No pharmacologic dilation · 848 by 848 pixels · 45-degree field of view:
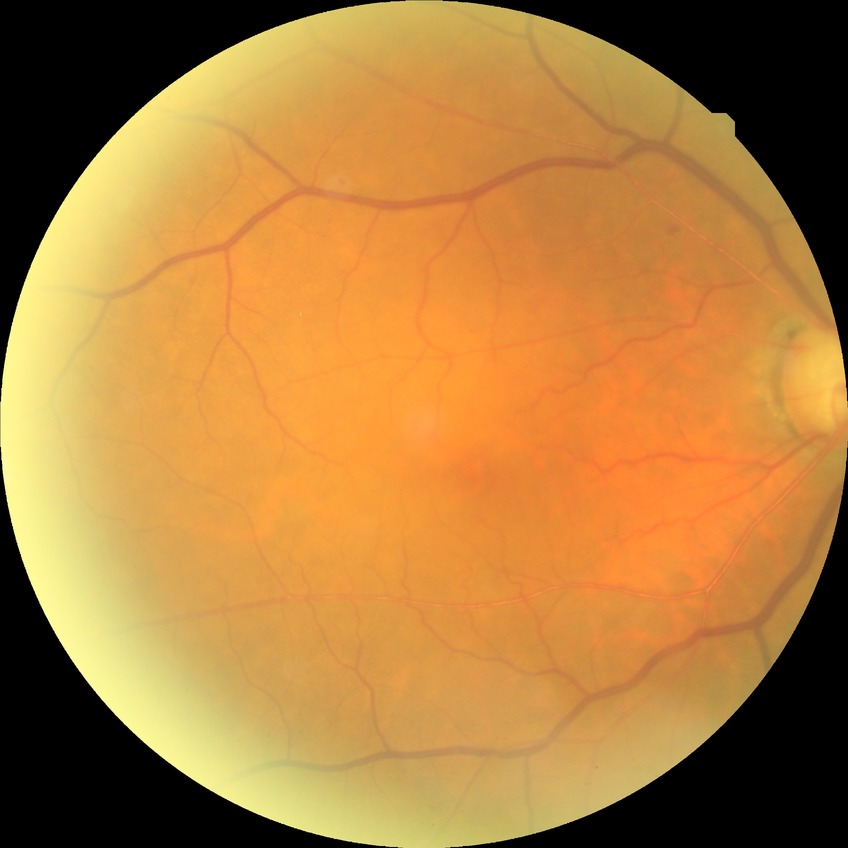
Diabetic retinopathy (DR) is SDR (simple diabetic retinopathy).